45° field of view: 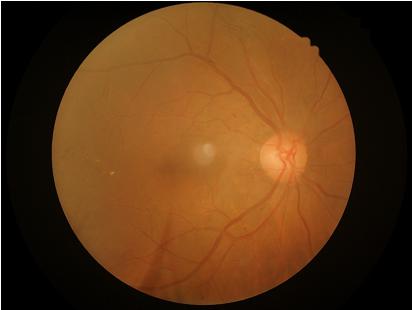 Image quality assessment:
- clarity: clear with no noticeable blur
- overall: good and suitable for diagnostic use
- contrast: vessels and details readily distinguishable